848 x 848 pixels · fundus photo · camera: NIDEK AFC-230 · modified Davis classification
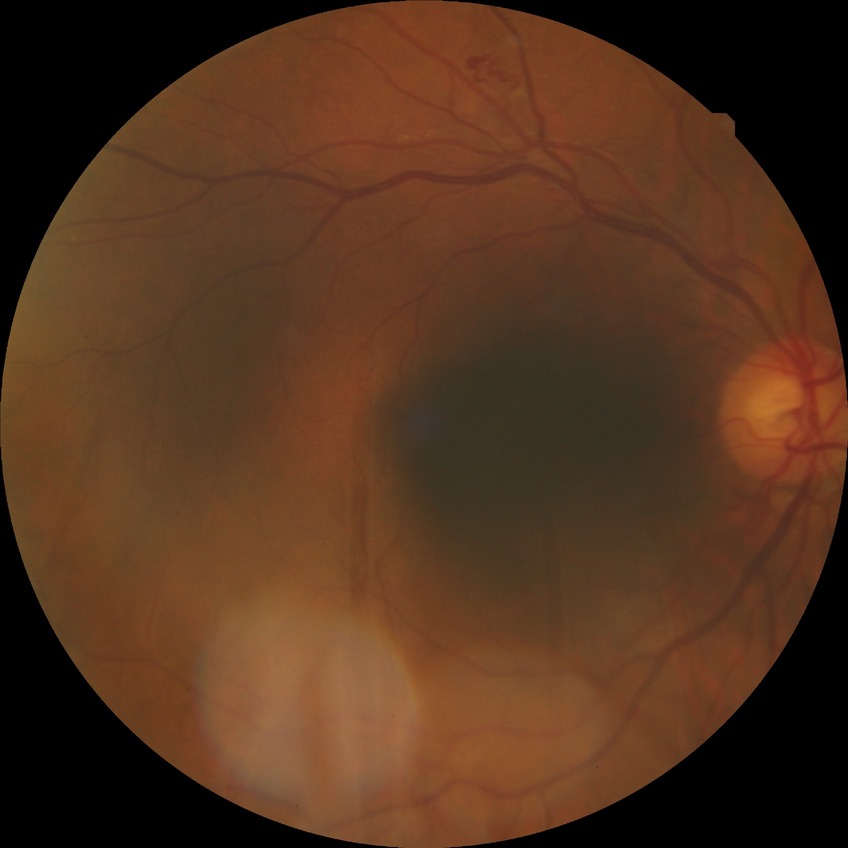 diabetic retinopathy (DR)=proliferative diabetic retinopathy (PDR).